Modified Davis classification · image size 848x848 · 45° field of view
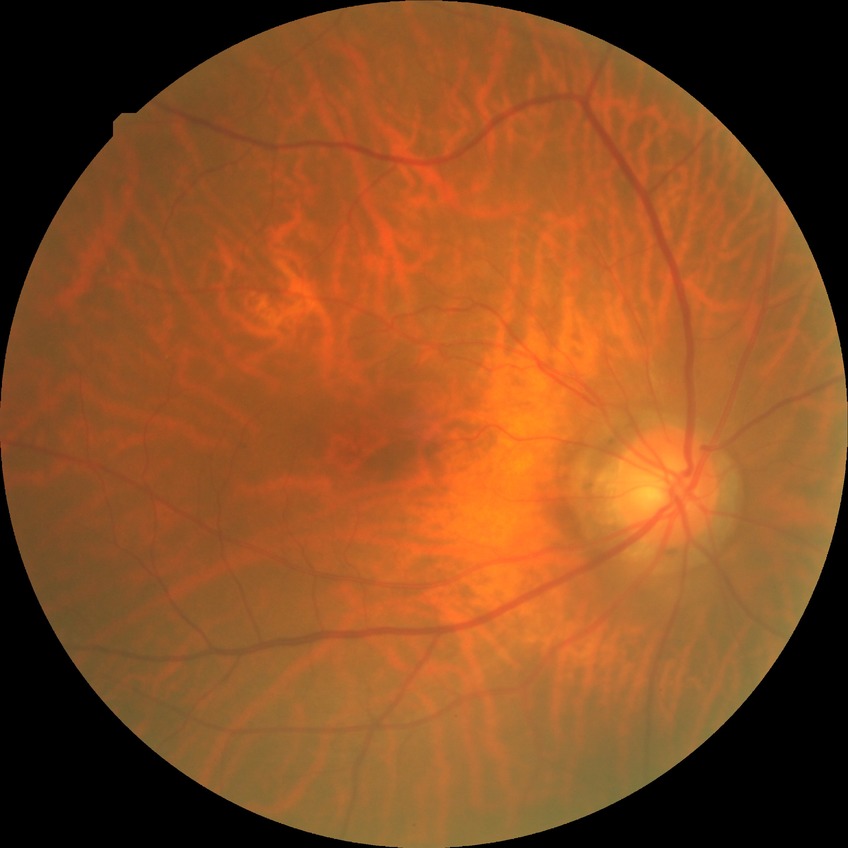 Diabetic retinopathy (DR): no diabetic retinopathy (NDR).